2352x1568: 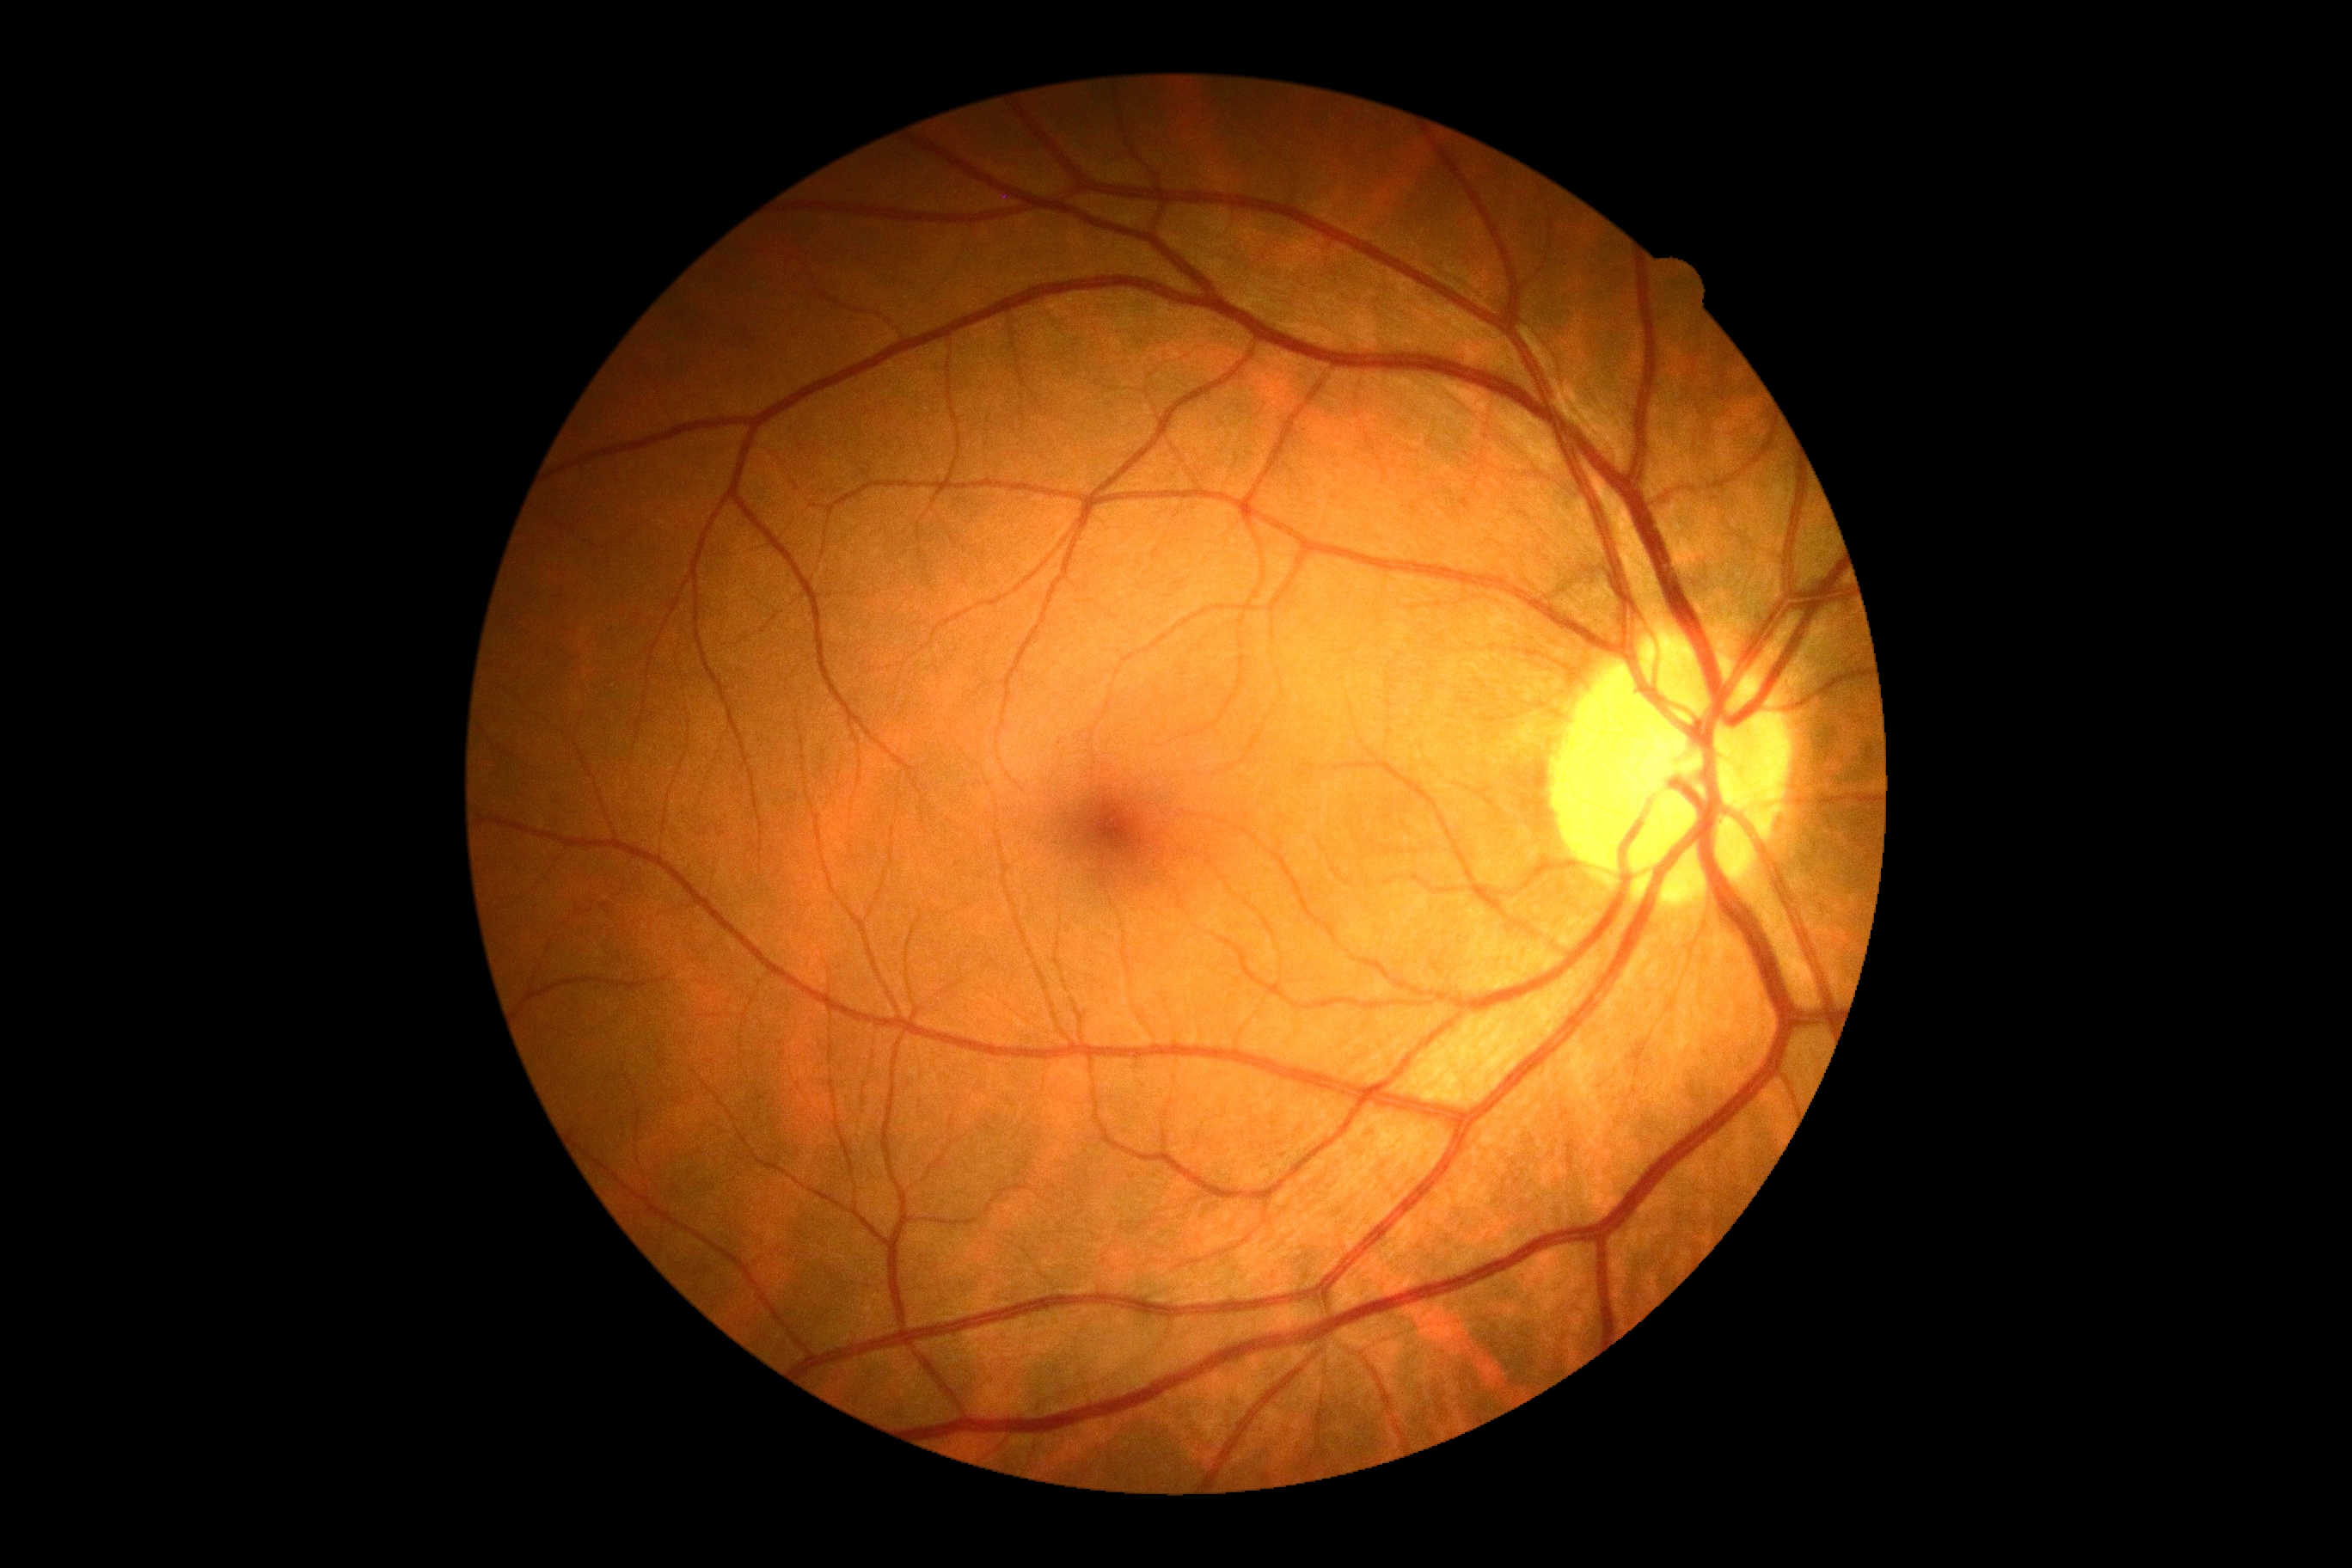

No diabetic retinal disease findings.
DR: 0/4.